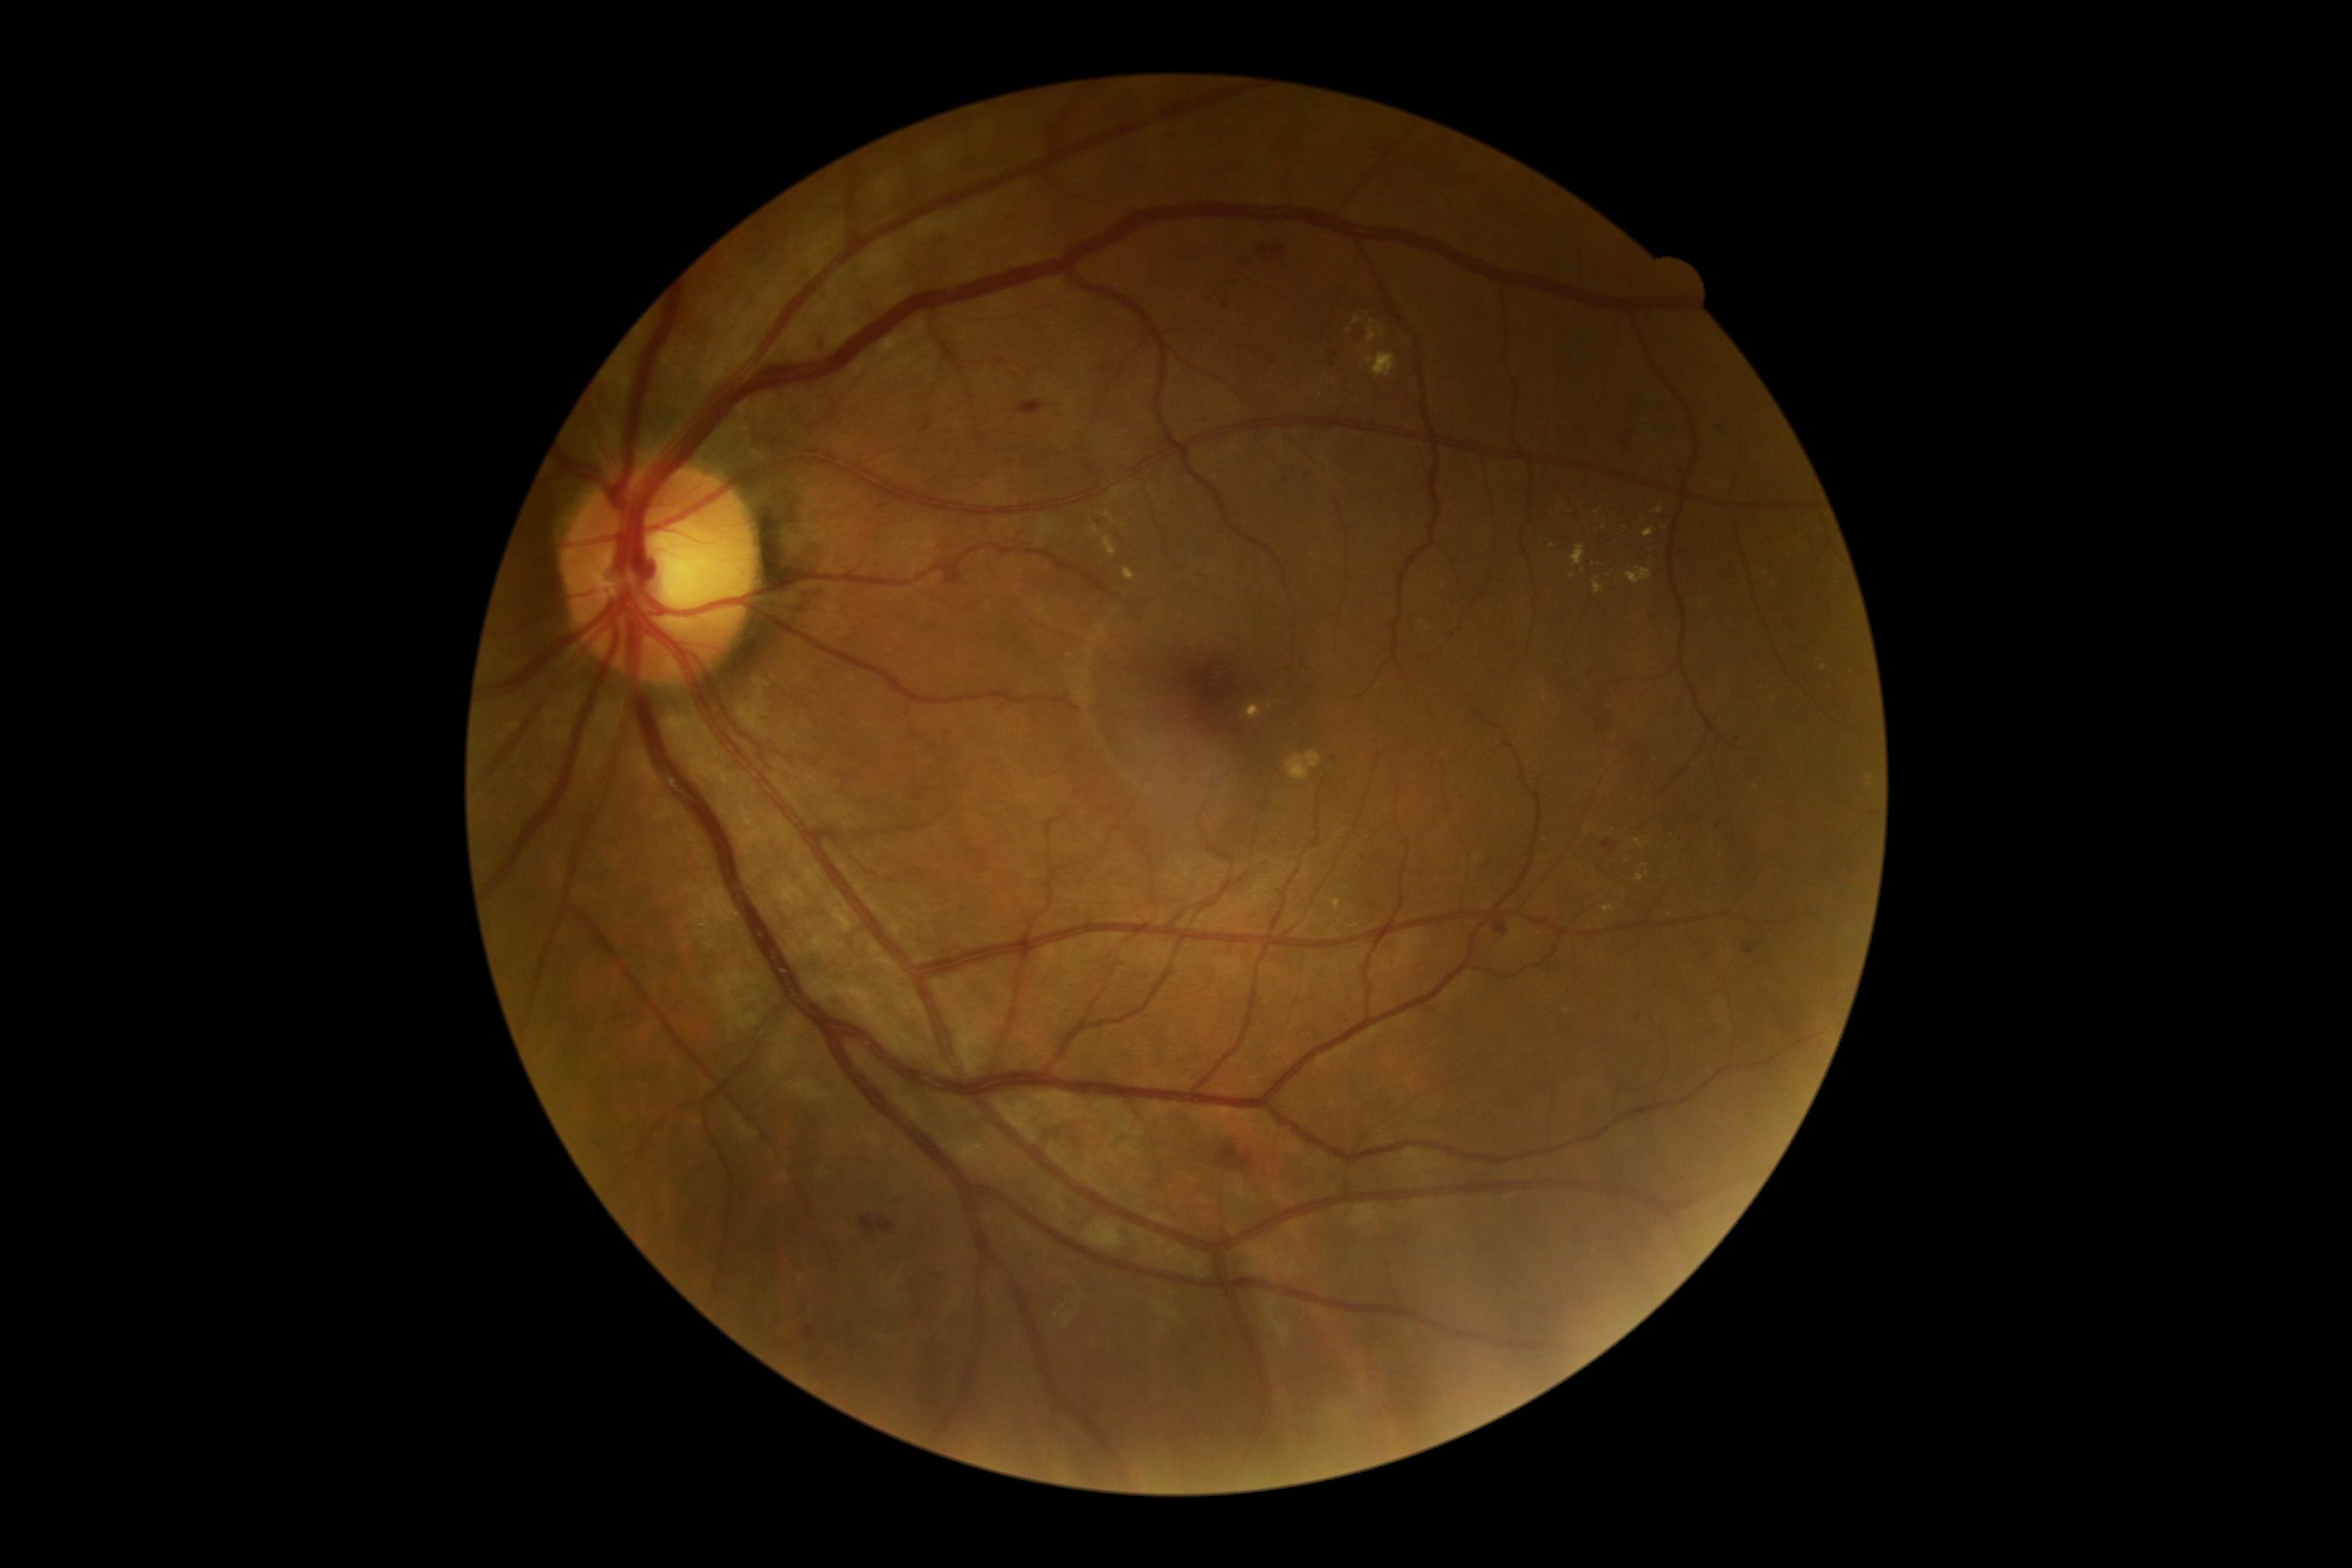 <lesions partial="true">
  <dr_grade>2</dr_grade>
  <ex partial="true">1366, 353, 1395, 379; 1091, 525, 1101, 536; 1636, 840, 1645, 848; 1603, 905, 1615, 914; 1368, 319, 1376, 343; 1572, 546, 1586, 567; 1352, 315, 1361, 326; 1650, 563, 1660, 570; 1643, 527, 1655, 539</ex>
  <ex_small_centers>x=1552, y=546; x=1643, y=865; x=1620, y=521; x=1605, y=528; x=1597, y=514; x=1629, y=530</ex_small_centers>
  <ma partial="true">1715, 819, 1722, 828; 1297, 157, 1304, 169; 805, 1328, 814, 1340; 1677, 831, 1682, 840; 1636, 1014, 1643, 1022; 814, 333, 830, 352; 1318, 969, 1323, 977</ma>
  <ma_small_centers>x=920, y=799; x=1746, y=870; x=1452, y=635; x=1282, y=482; x=1307, y=475; x=1590, y=671</ma_small_centers>
  <he partial="true">1602, 840, 1617, 857; 1259, 247, 1283, 255; 1717, 415, 1732, 431; 861, 1215, 895, 1235; 1493, 919, 1510, 938; 1744, 943, 1758, 955; 1230, 278, 1235, 286; 1718, 565, 1743, 580; 1220, 1144, 1256, 1172; 921, 424, 931, 432; 1624, 427, 1636, 450; 1356, 328, 1366, 340; 1015, 400, 1048, 415; 1330, 352, 1337, 365; 945, 565, 965, 584</he>
  <he_small_centers>x=1225, y=306; x=882, y=507; x=1243, y=257</he_small_centers>
  <se />
</lesions>